Camera: Topcon TRC-NW8
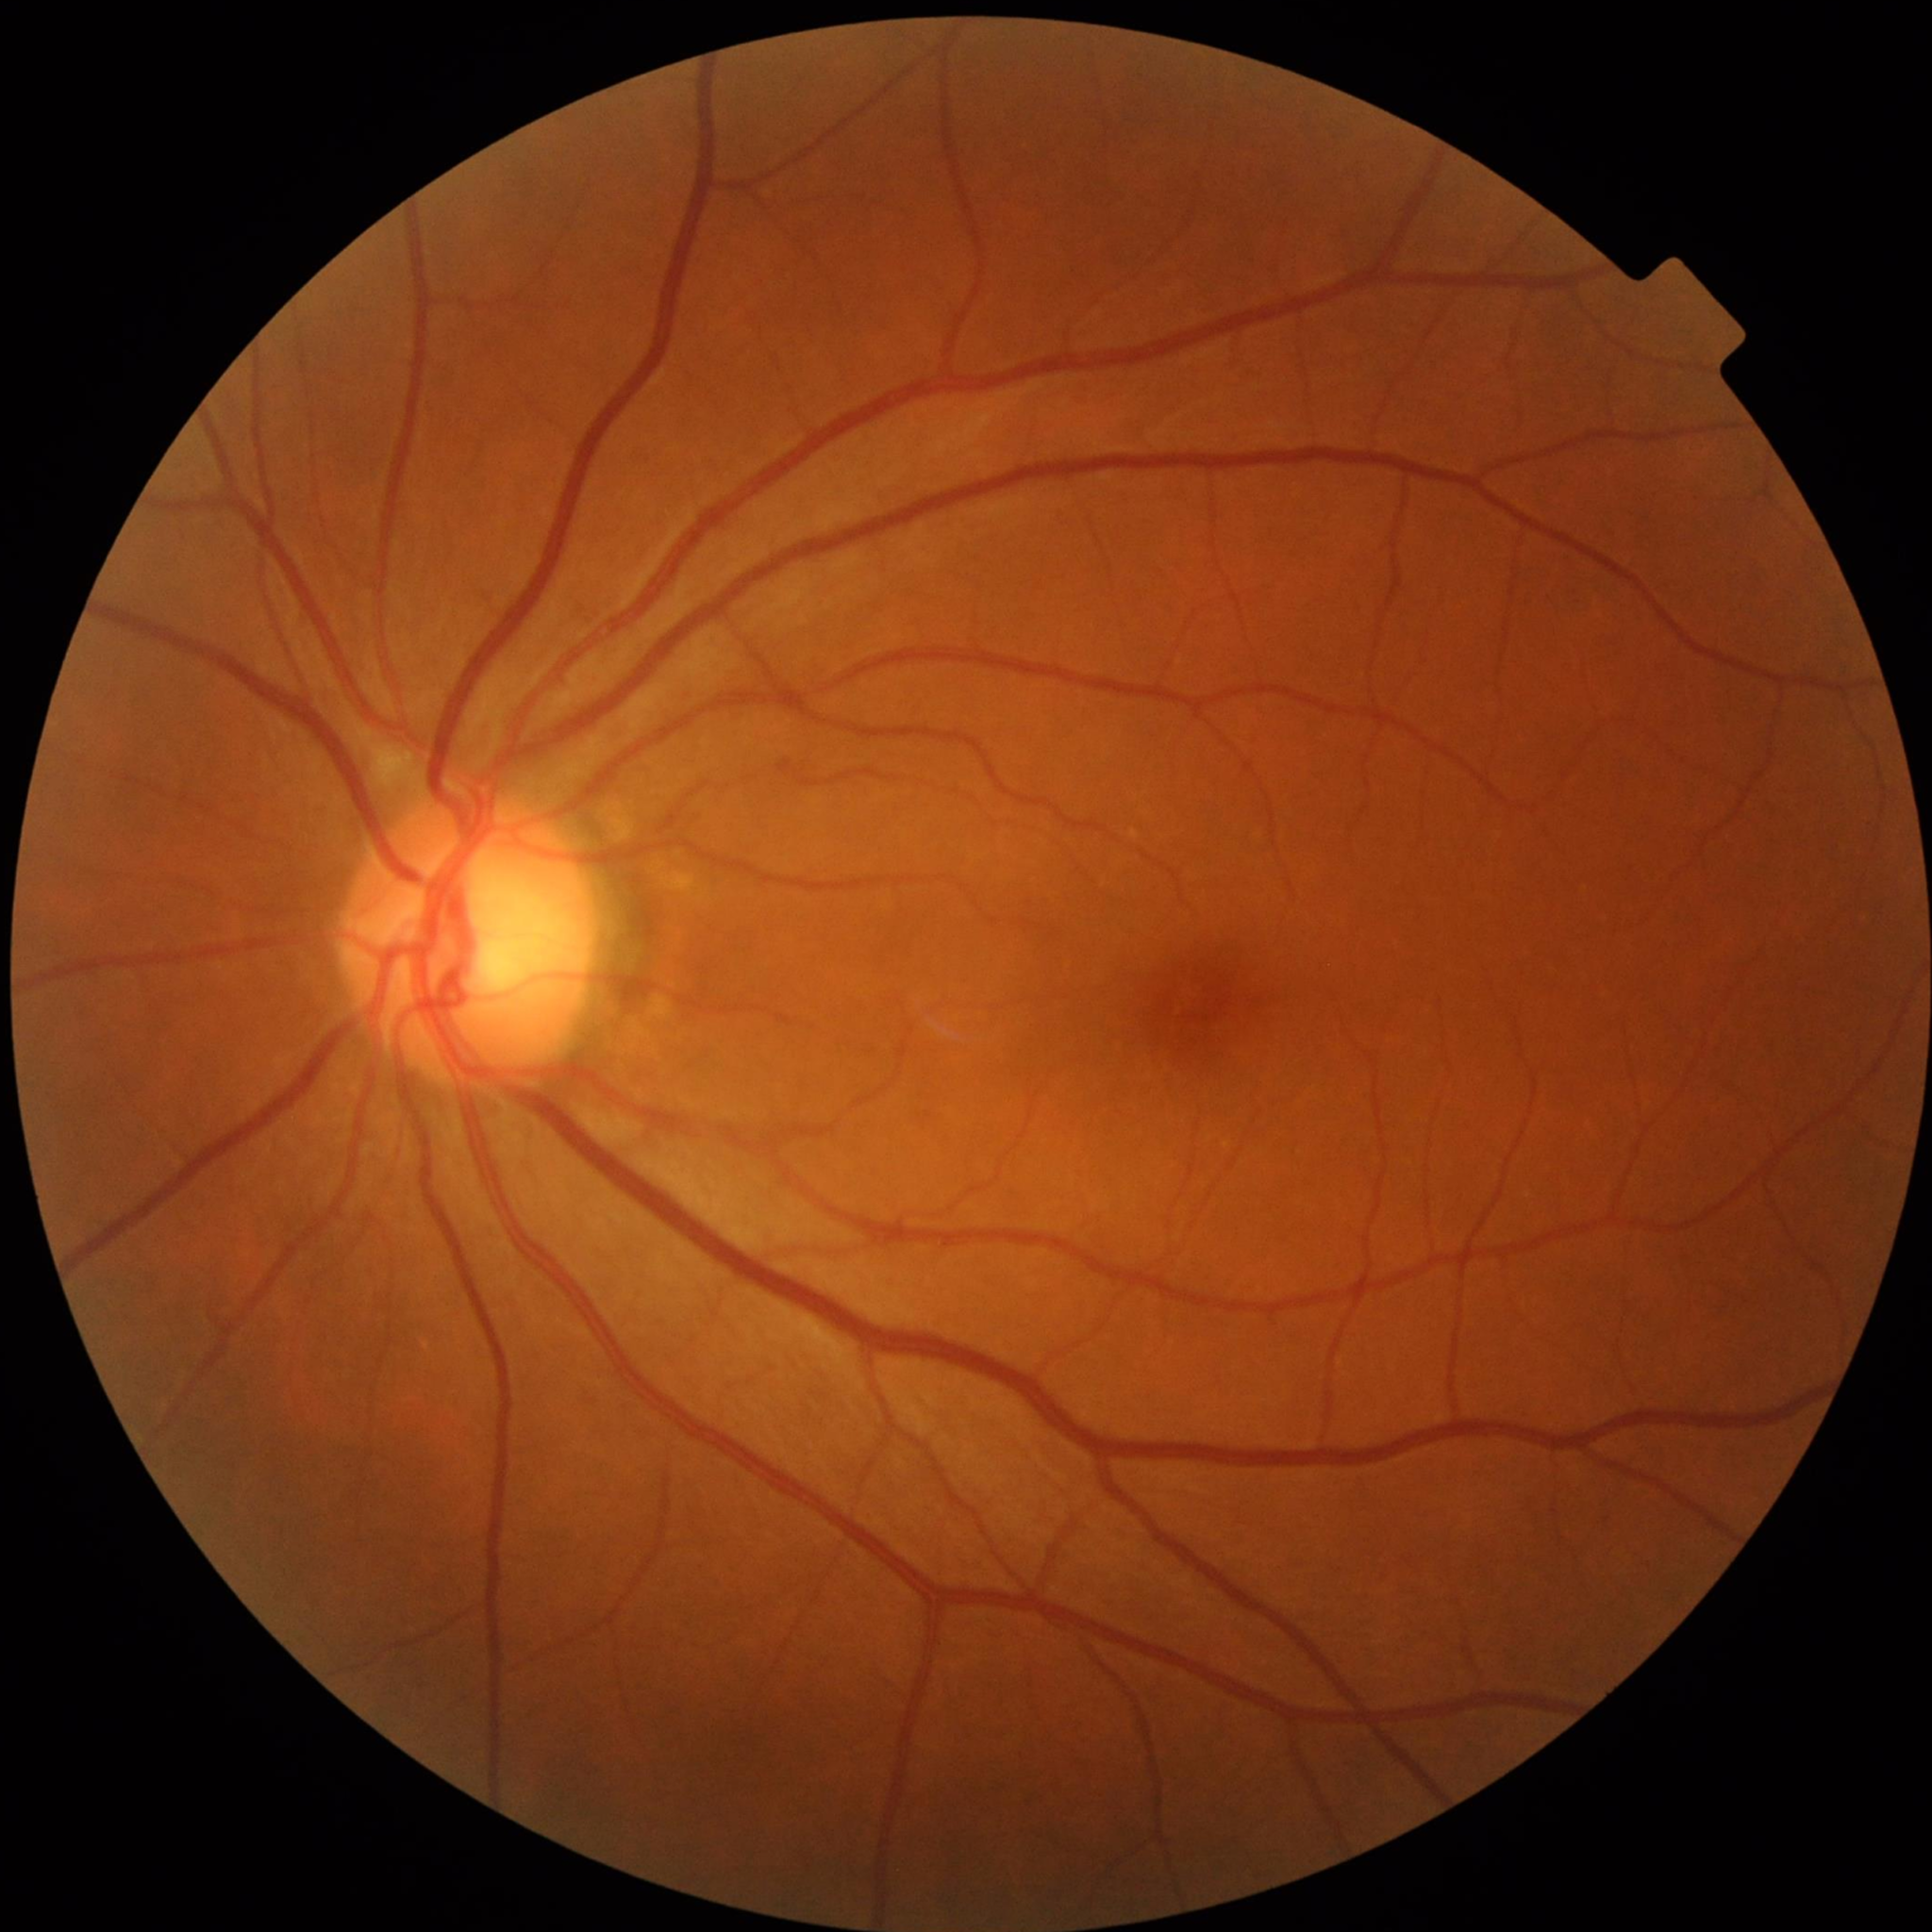
Control patient without diagnosed AMD, DR, or glaucoma.